Acquired with a NIDEK AFC-230; 848 by 848 pixels — 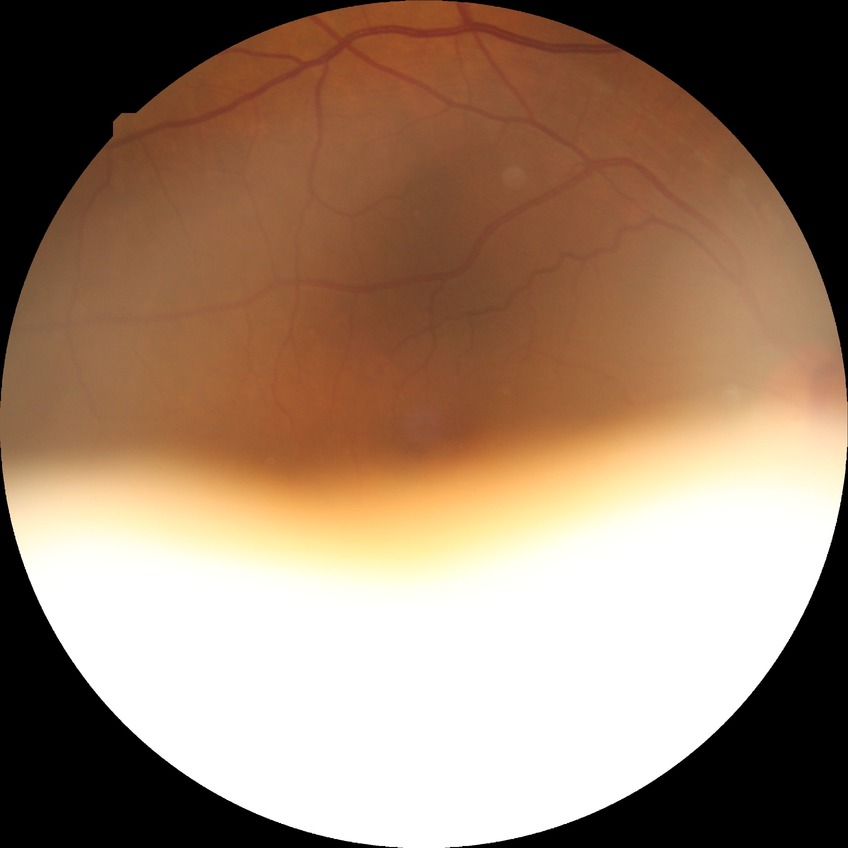

diabetic retinopathy stage = no diabetic retinopathy